45-degree field of view. Modified Davis classification. 848 x 848 pixels
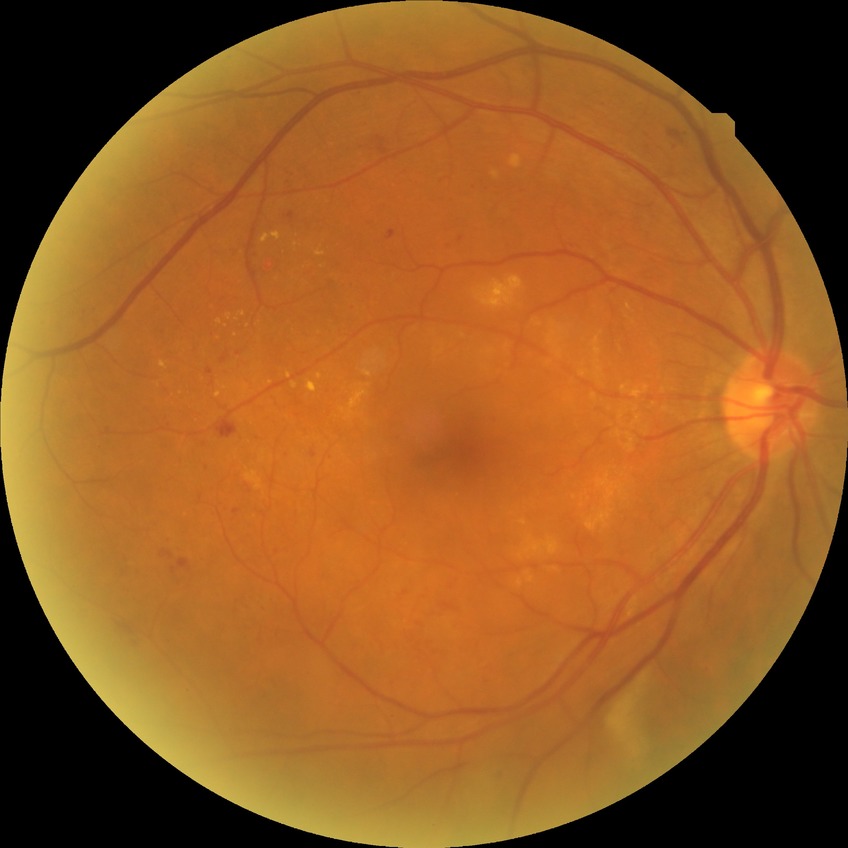 Retinopathy stage is simple diabetic retinopathy.
Disease class: non-proliferative diabetic retinopathy.